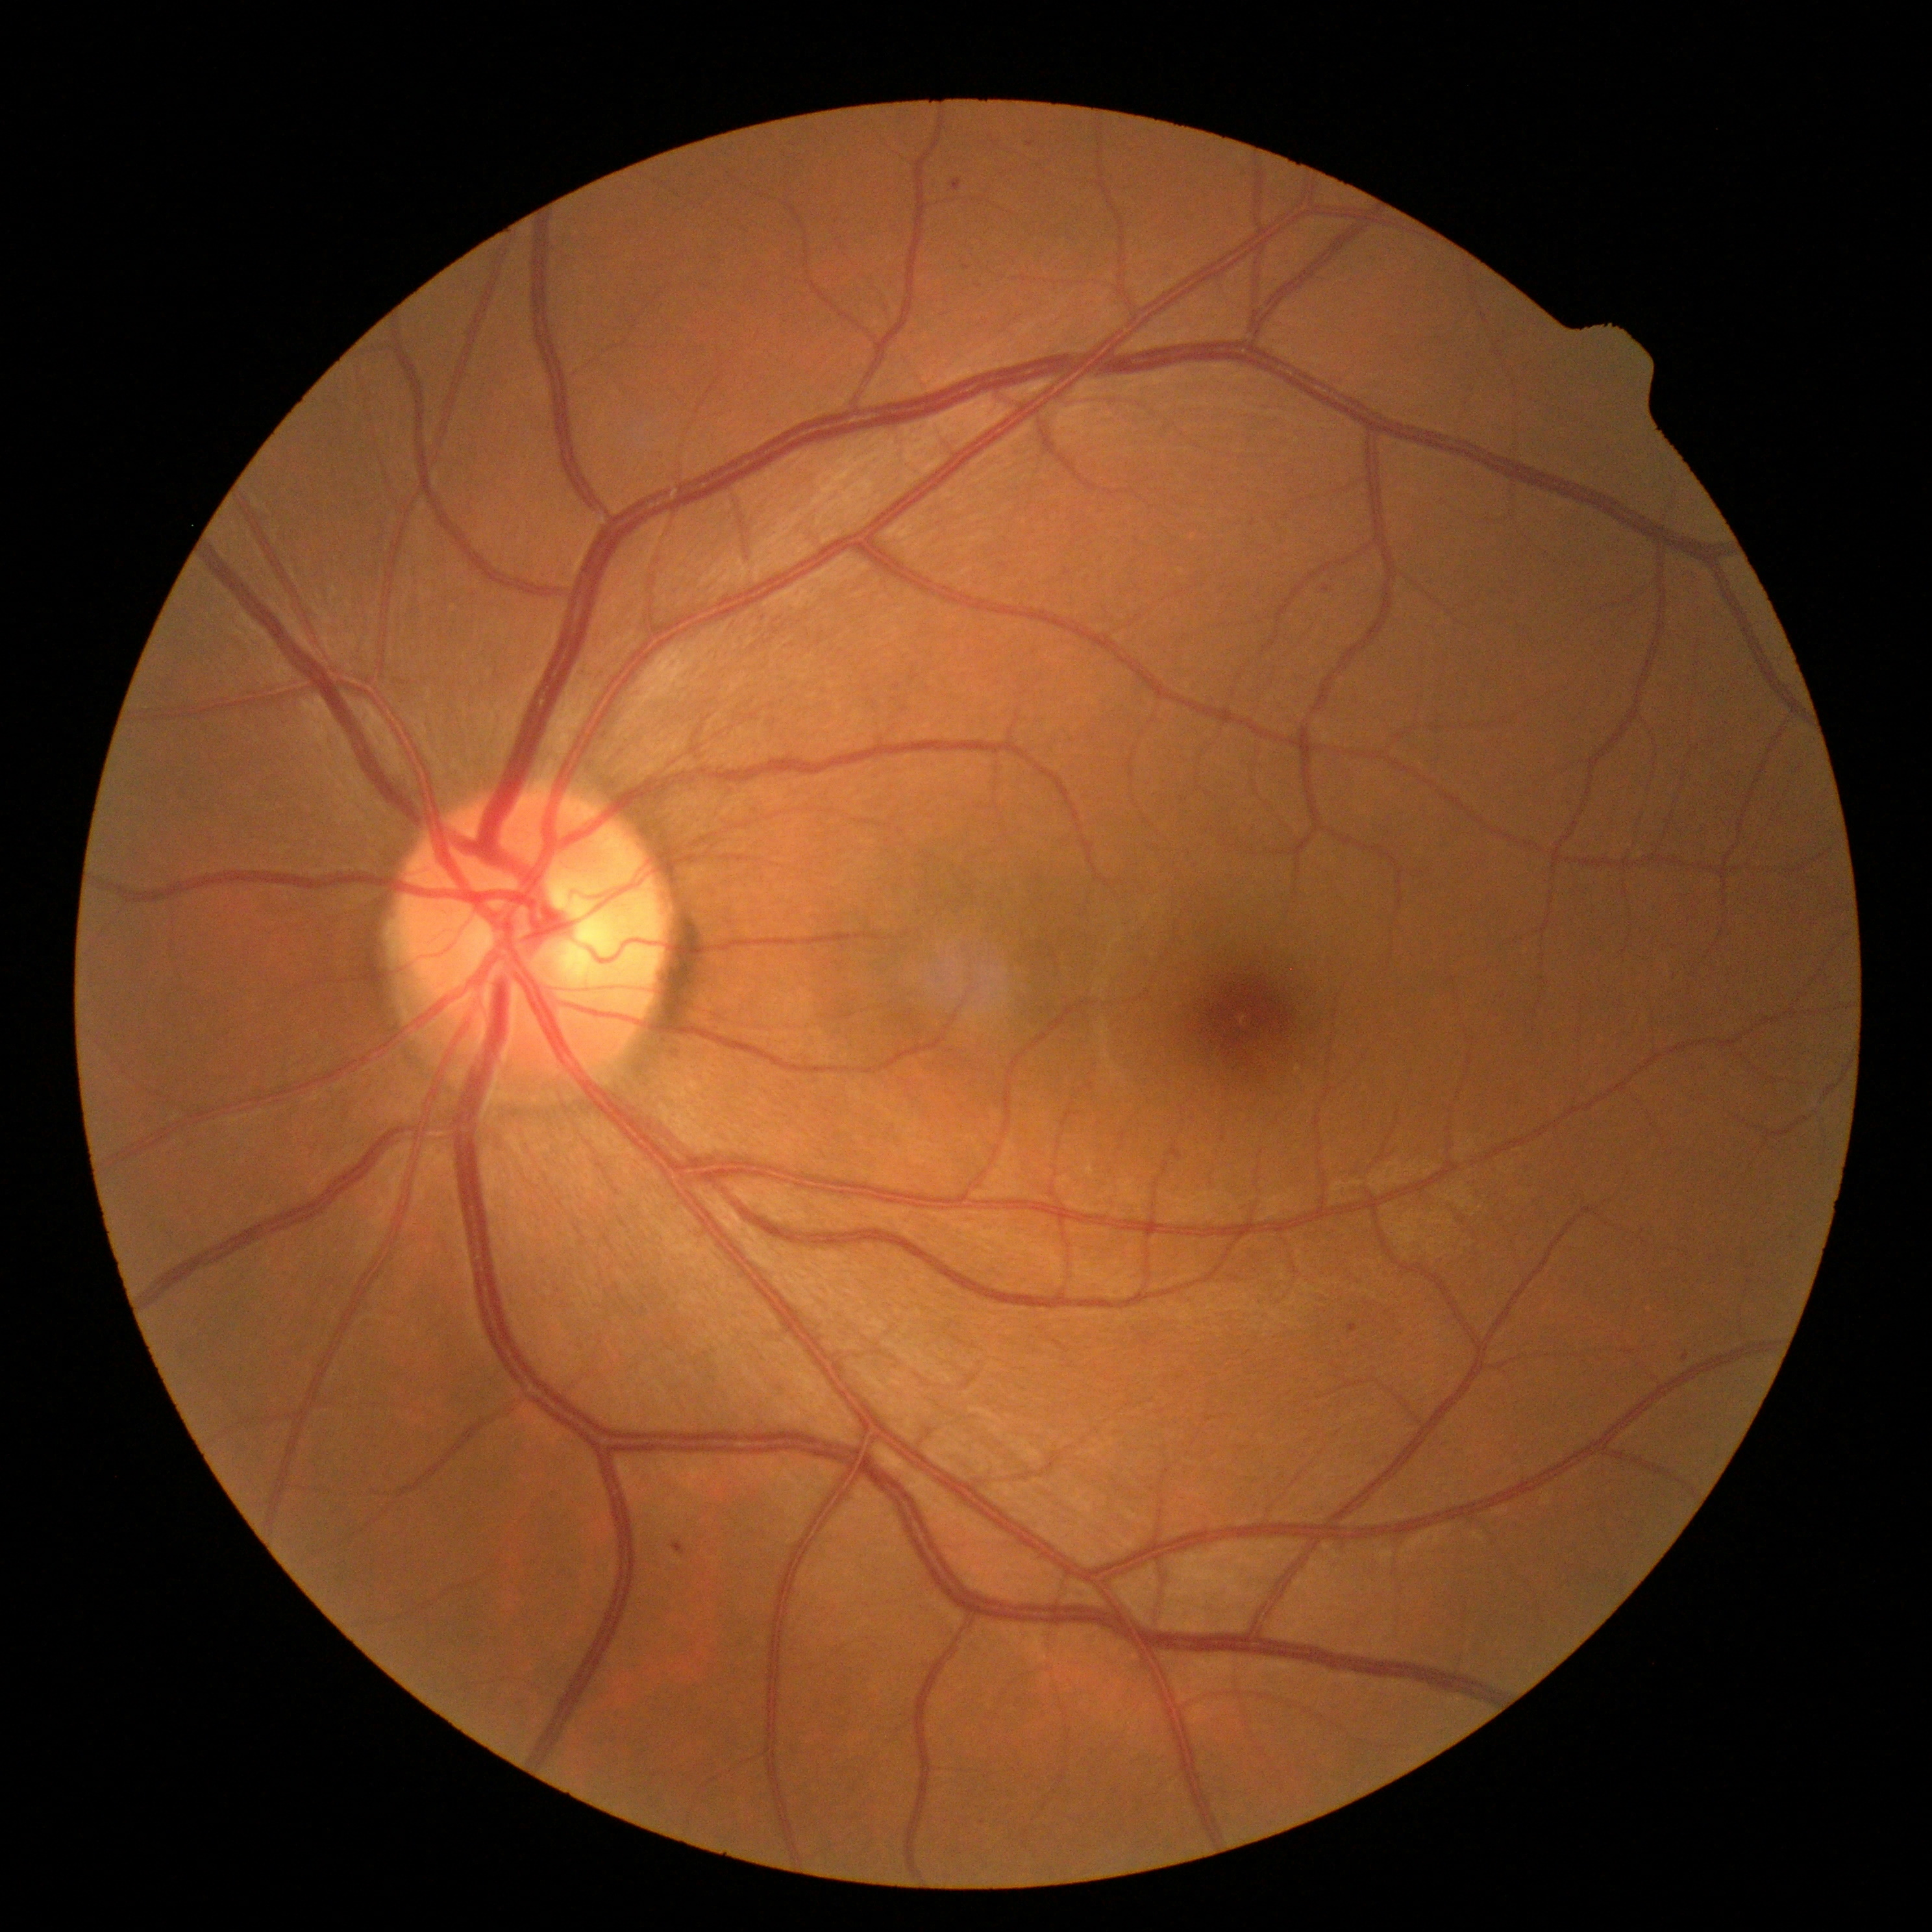

{
  "dr_grade": "mild NPDR (1)",
  "dr_category": "non-proliferative diabetic retinopathy"
}